No pharmacologic dilation — 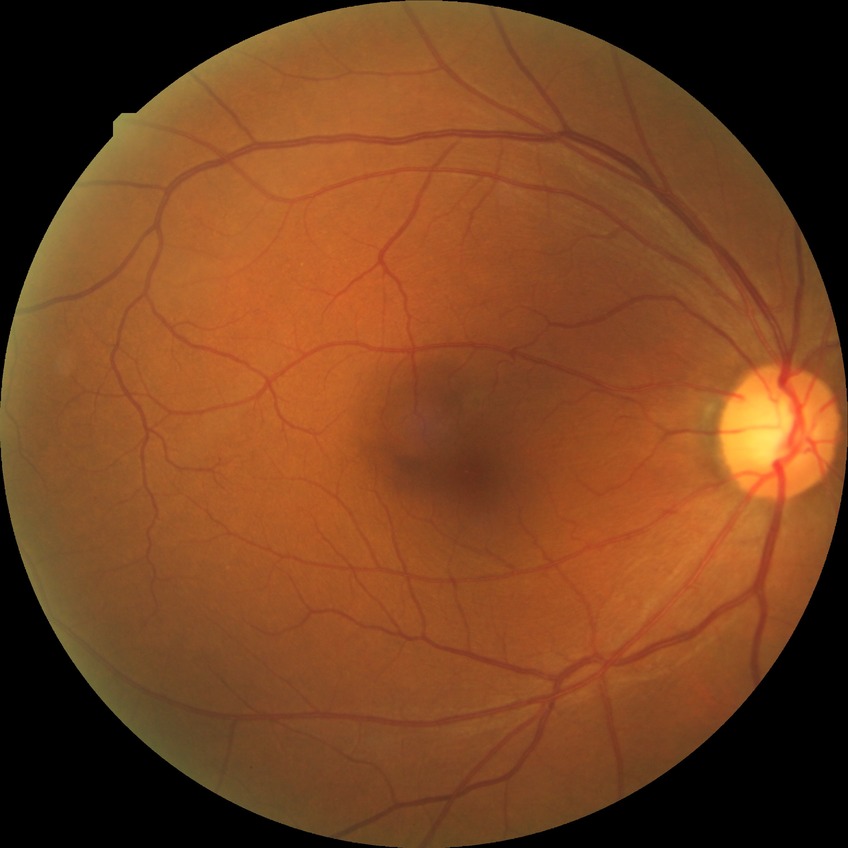
DR severity = NDR; DR impression = no signs of DR.